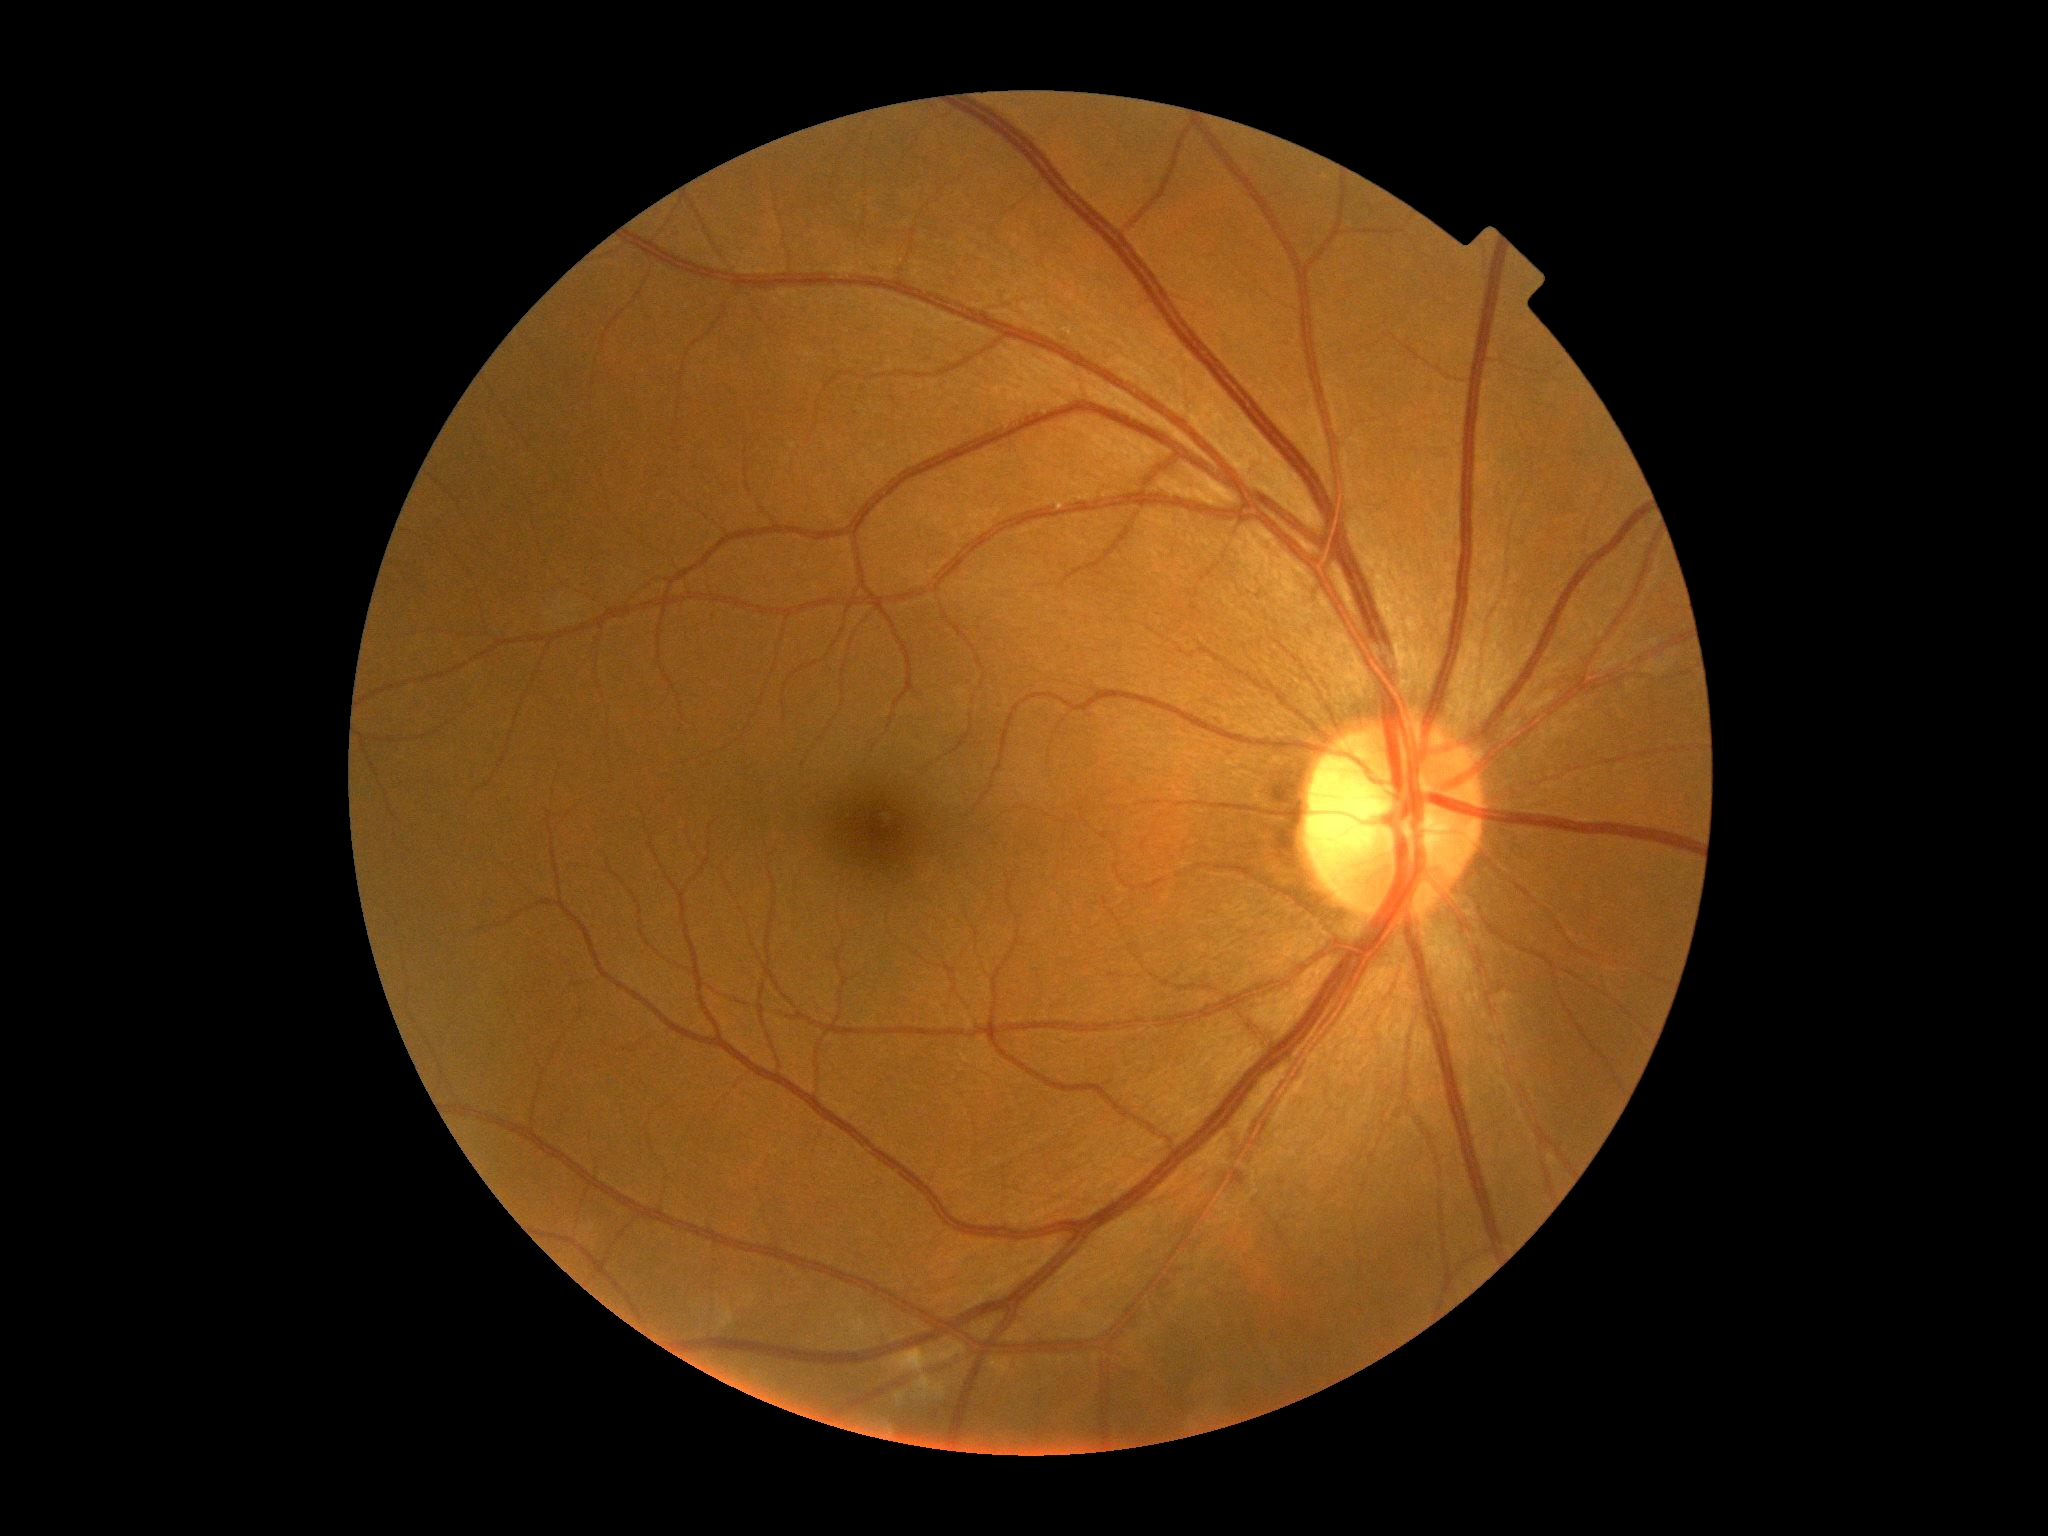
Annotations:
– DR stage: no apparent retinopathy (grade 0)